NIDEK AFC-230; nonmydriatic fundus photograph
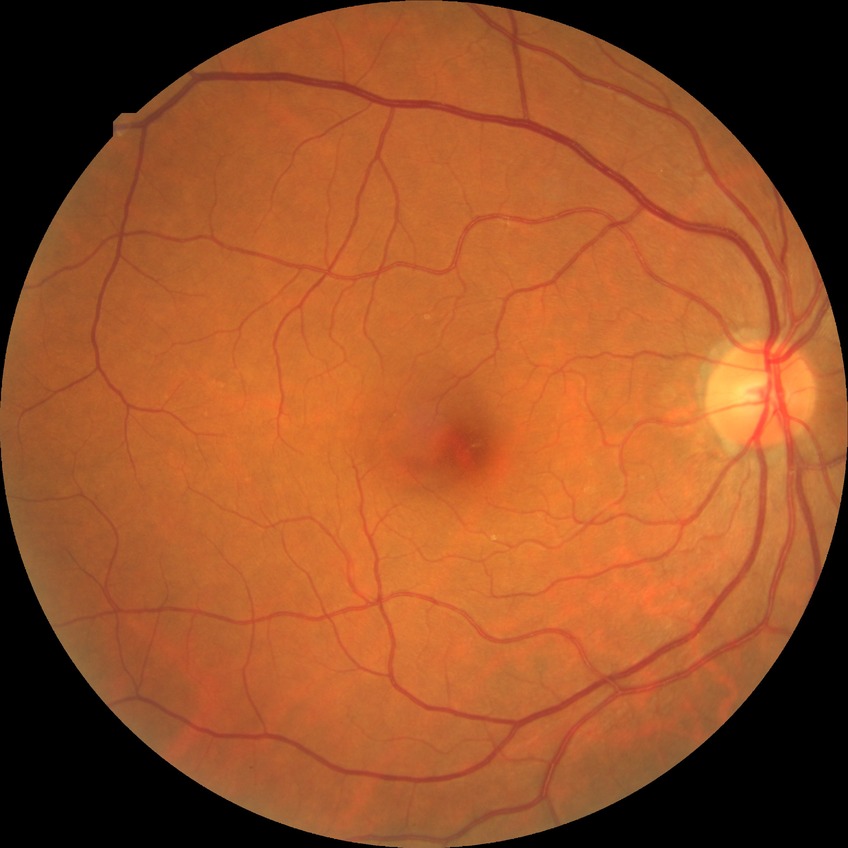

Davis grading is no diabetic retinopathy.